50° FOV. 1932 by 1932 pixels. Mydriatic (tropicamide phenylephrine 1.0%) — 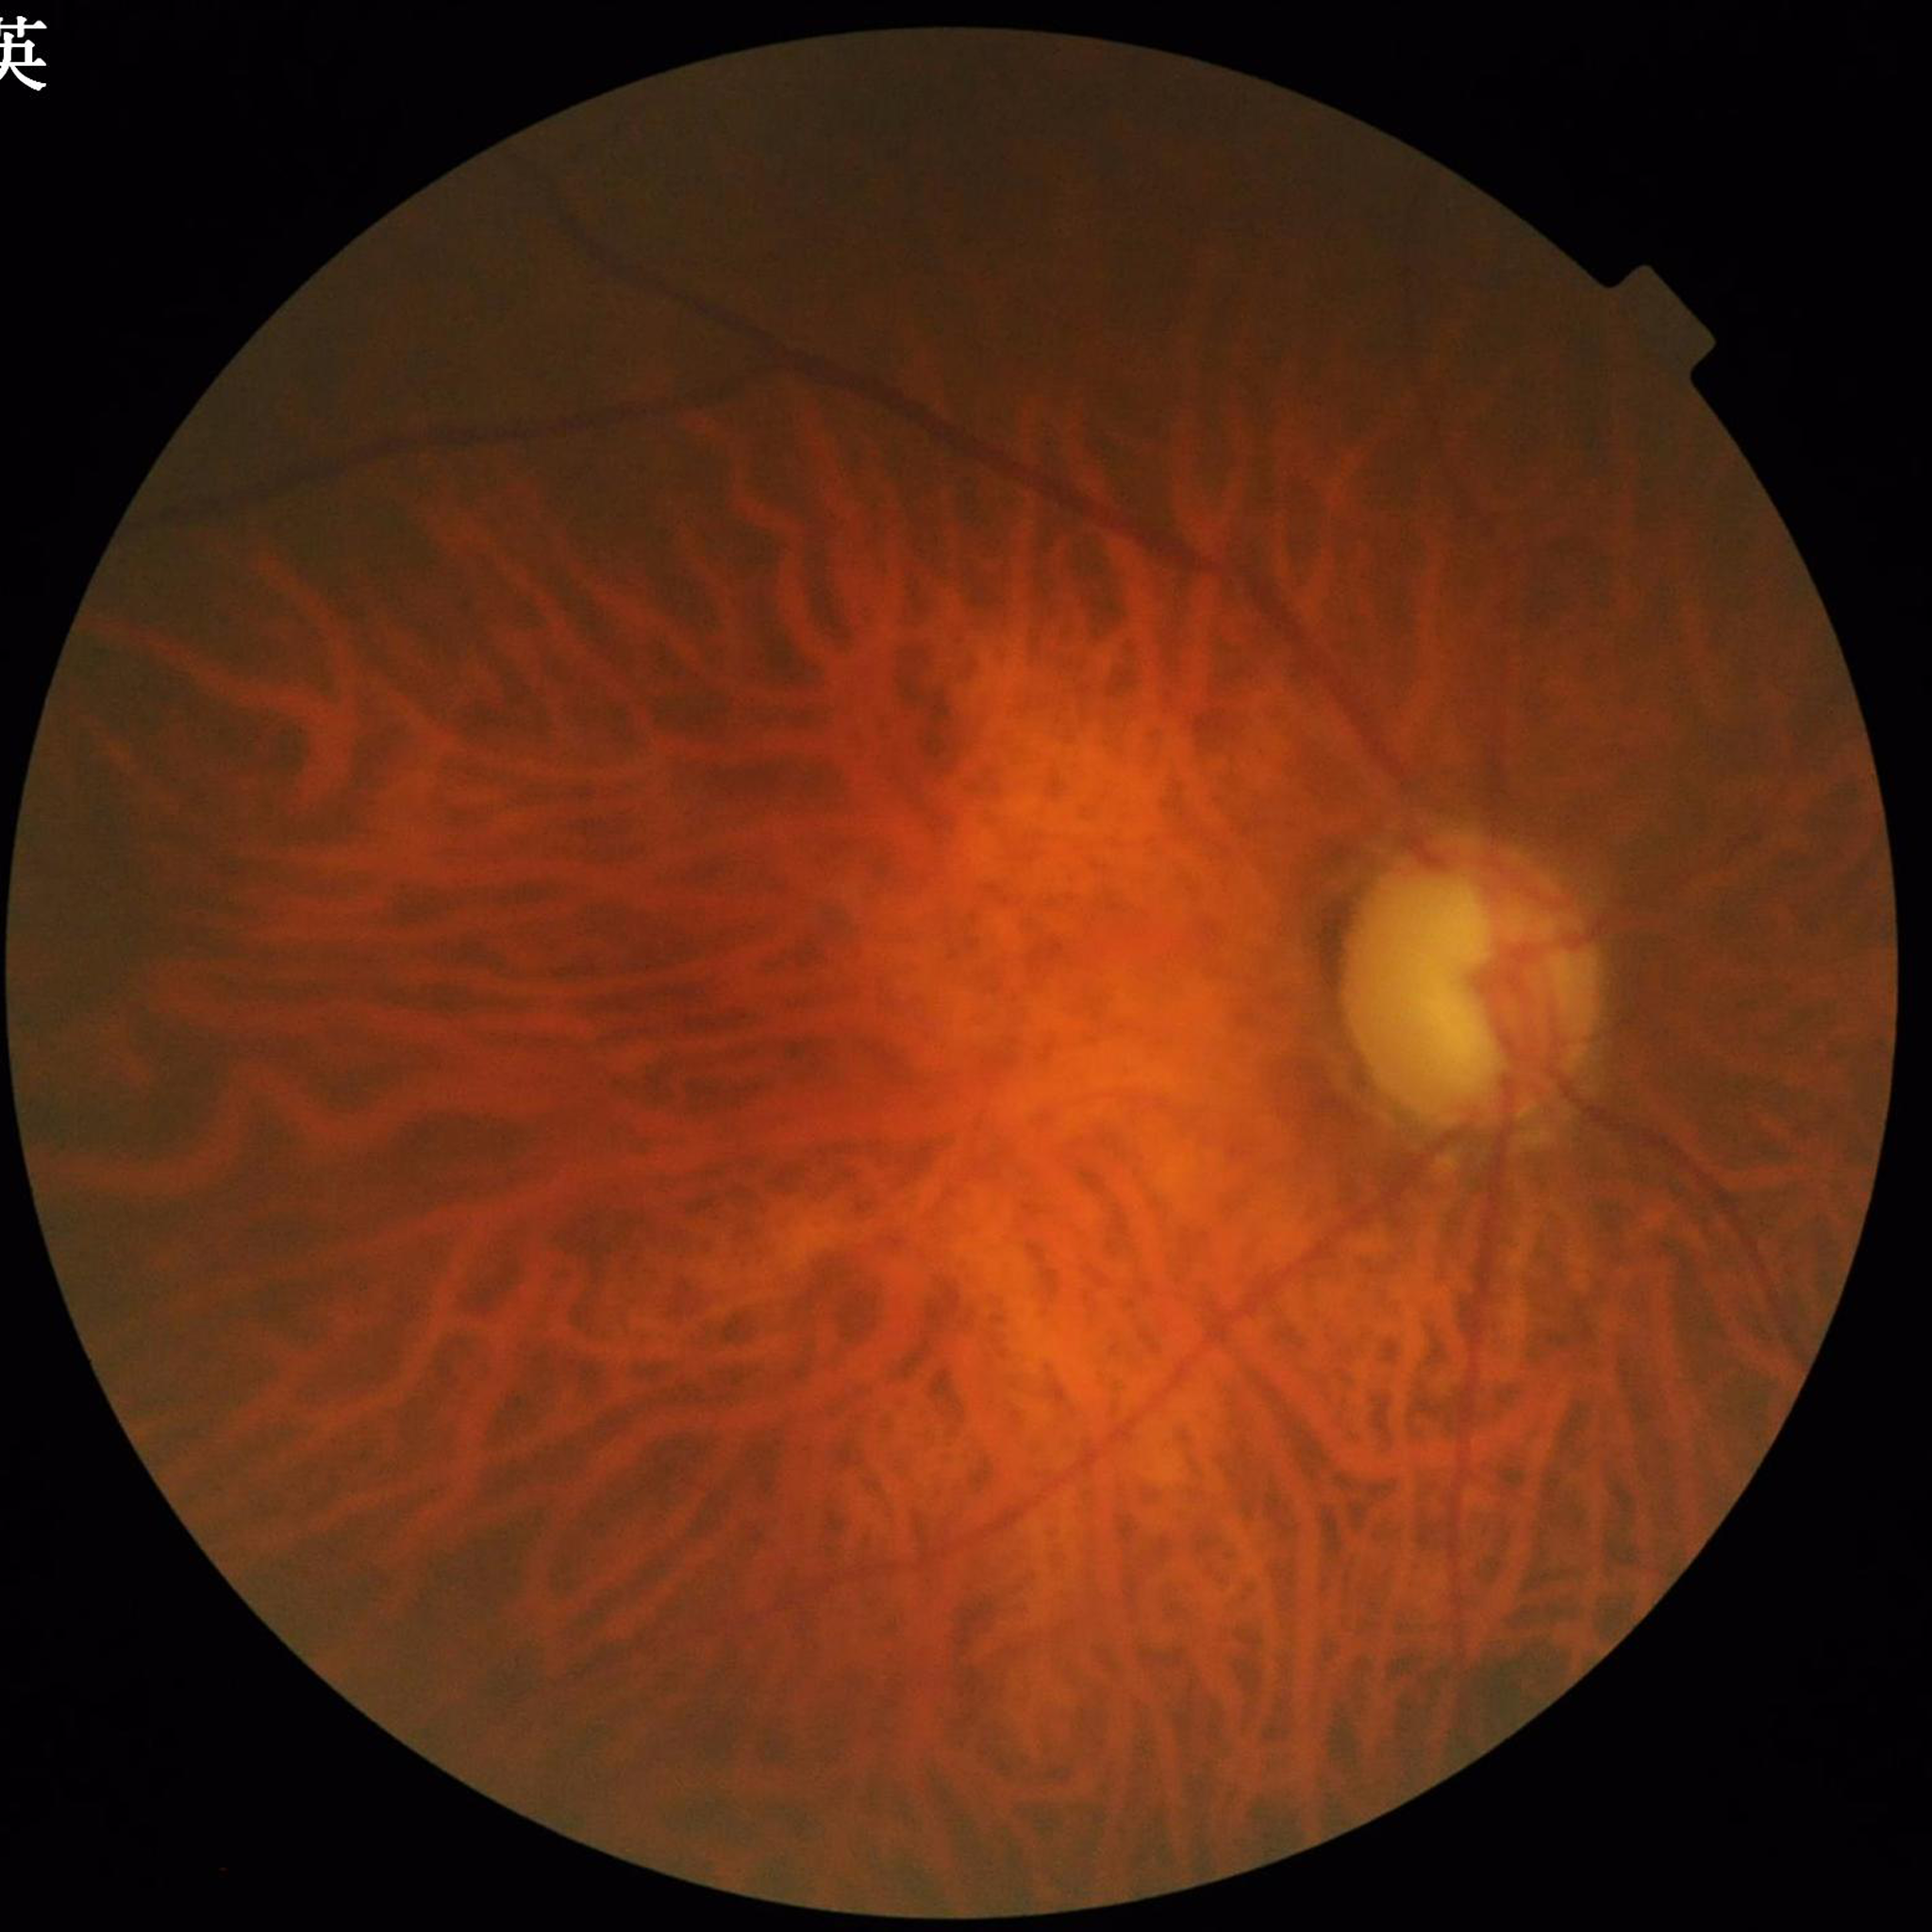
Image quality: contrast adequate, blur present, illumination/color distortion present.
This fundus photograph is from a patient diagnosed with glaucoma.